2352 x 1568 pixels · 45-degree field of view
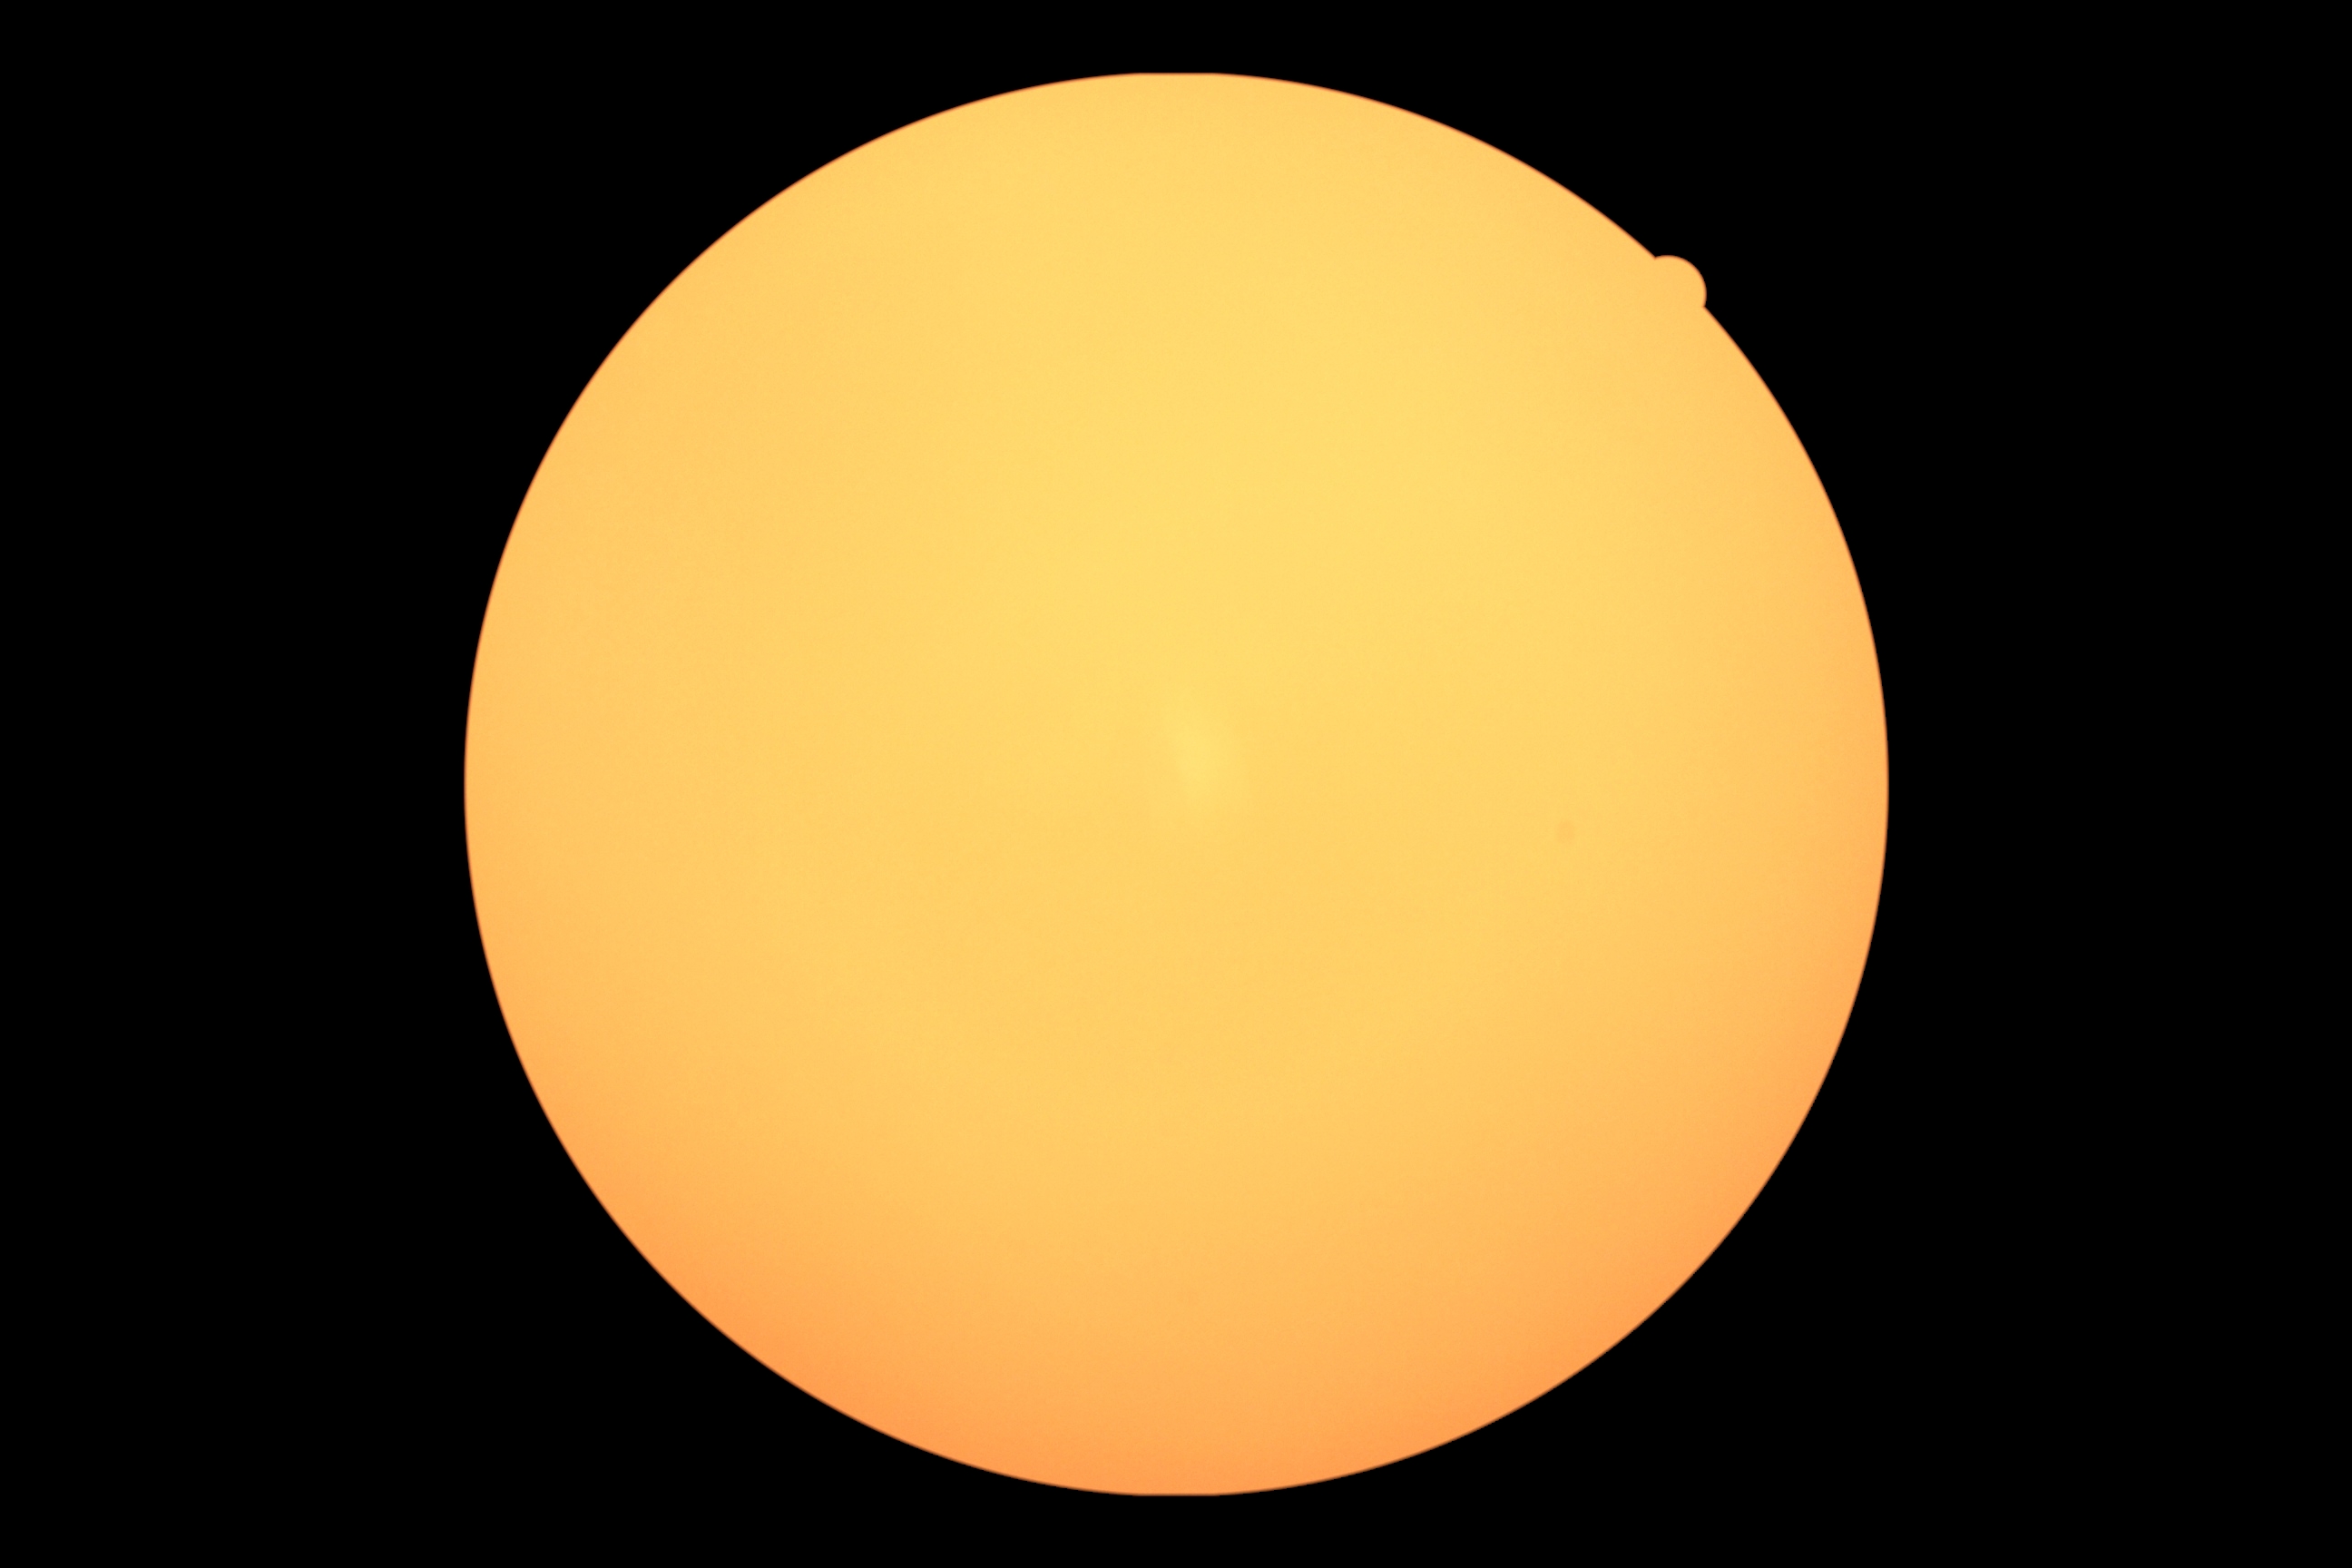
diabetic retinopathy (DR)=ungradable due to poor image quality.